Modified Davis grading; nonmydriatic
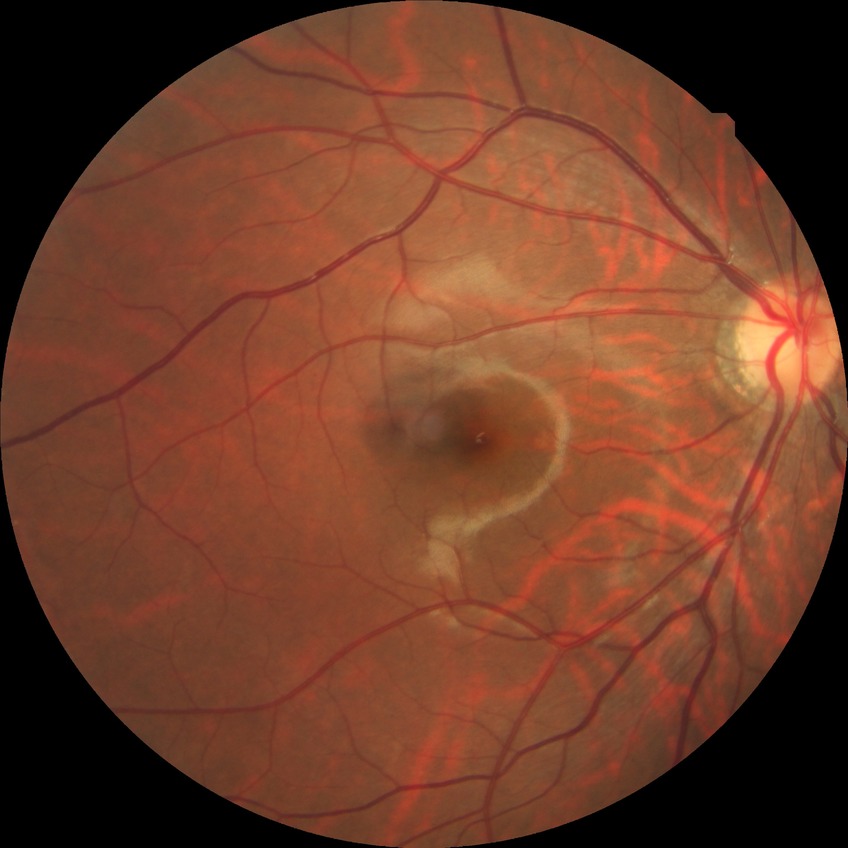

diabetic retinopathy grade = no diabetic retinopathy.